Captured on a Nidek AFC-330 fundus camera.
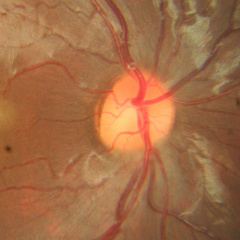

Color fundus photograph showing no glaucomatous changes.